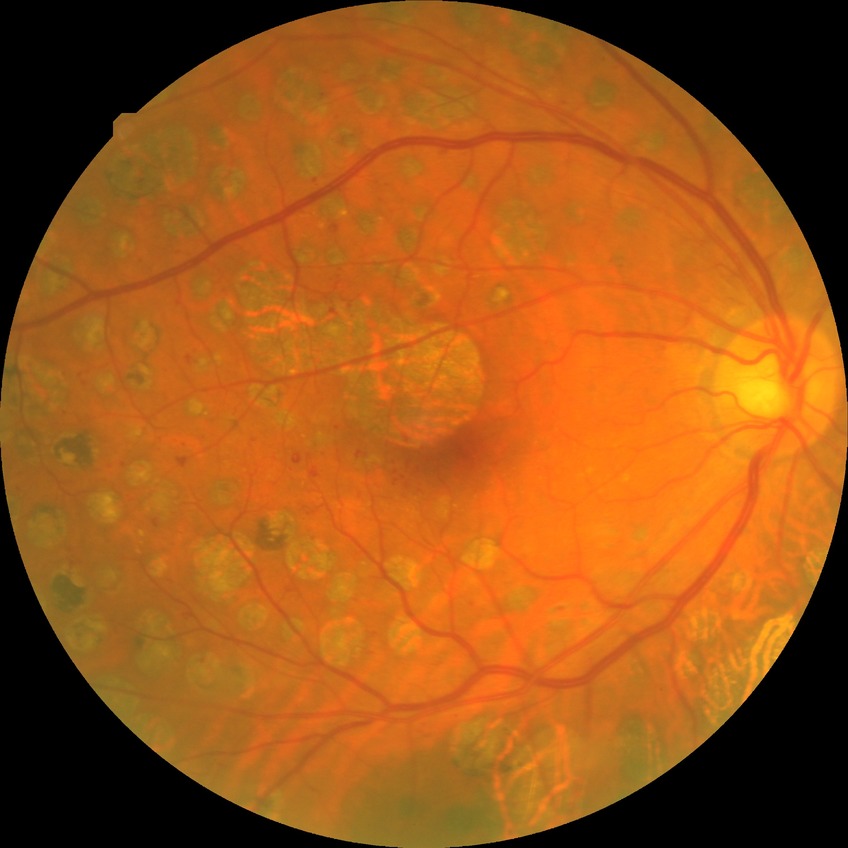 Diabetic retinopathy (DR) is PDR (proliferative diabetic retinopathy).